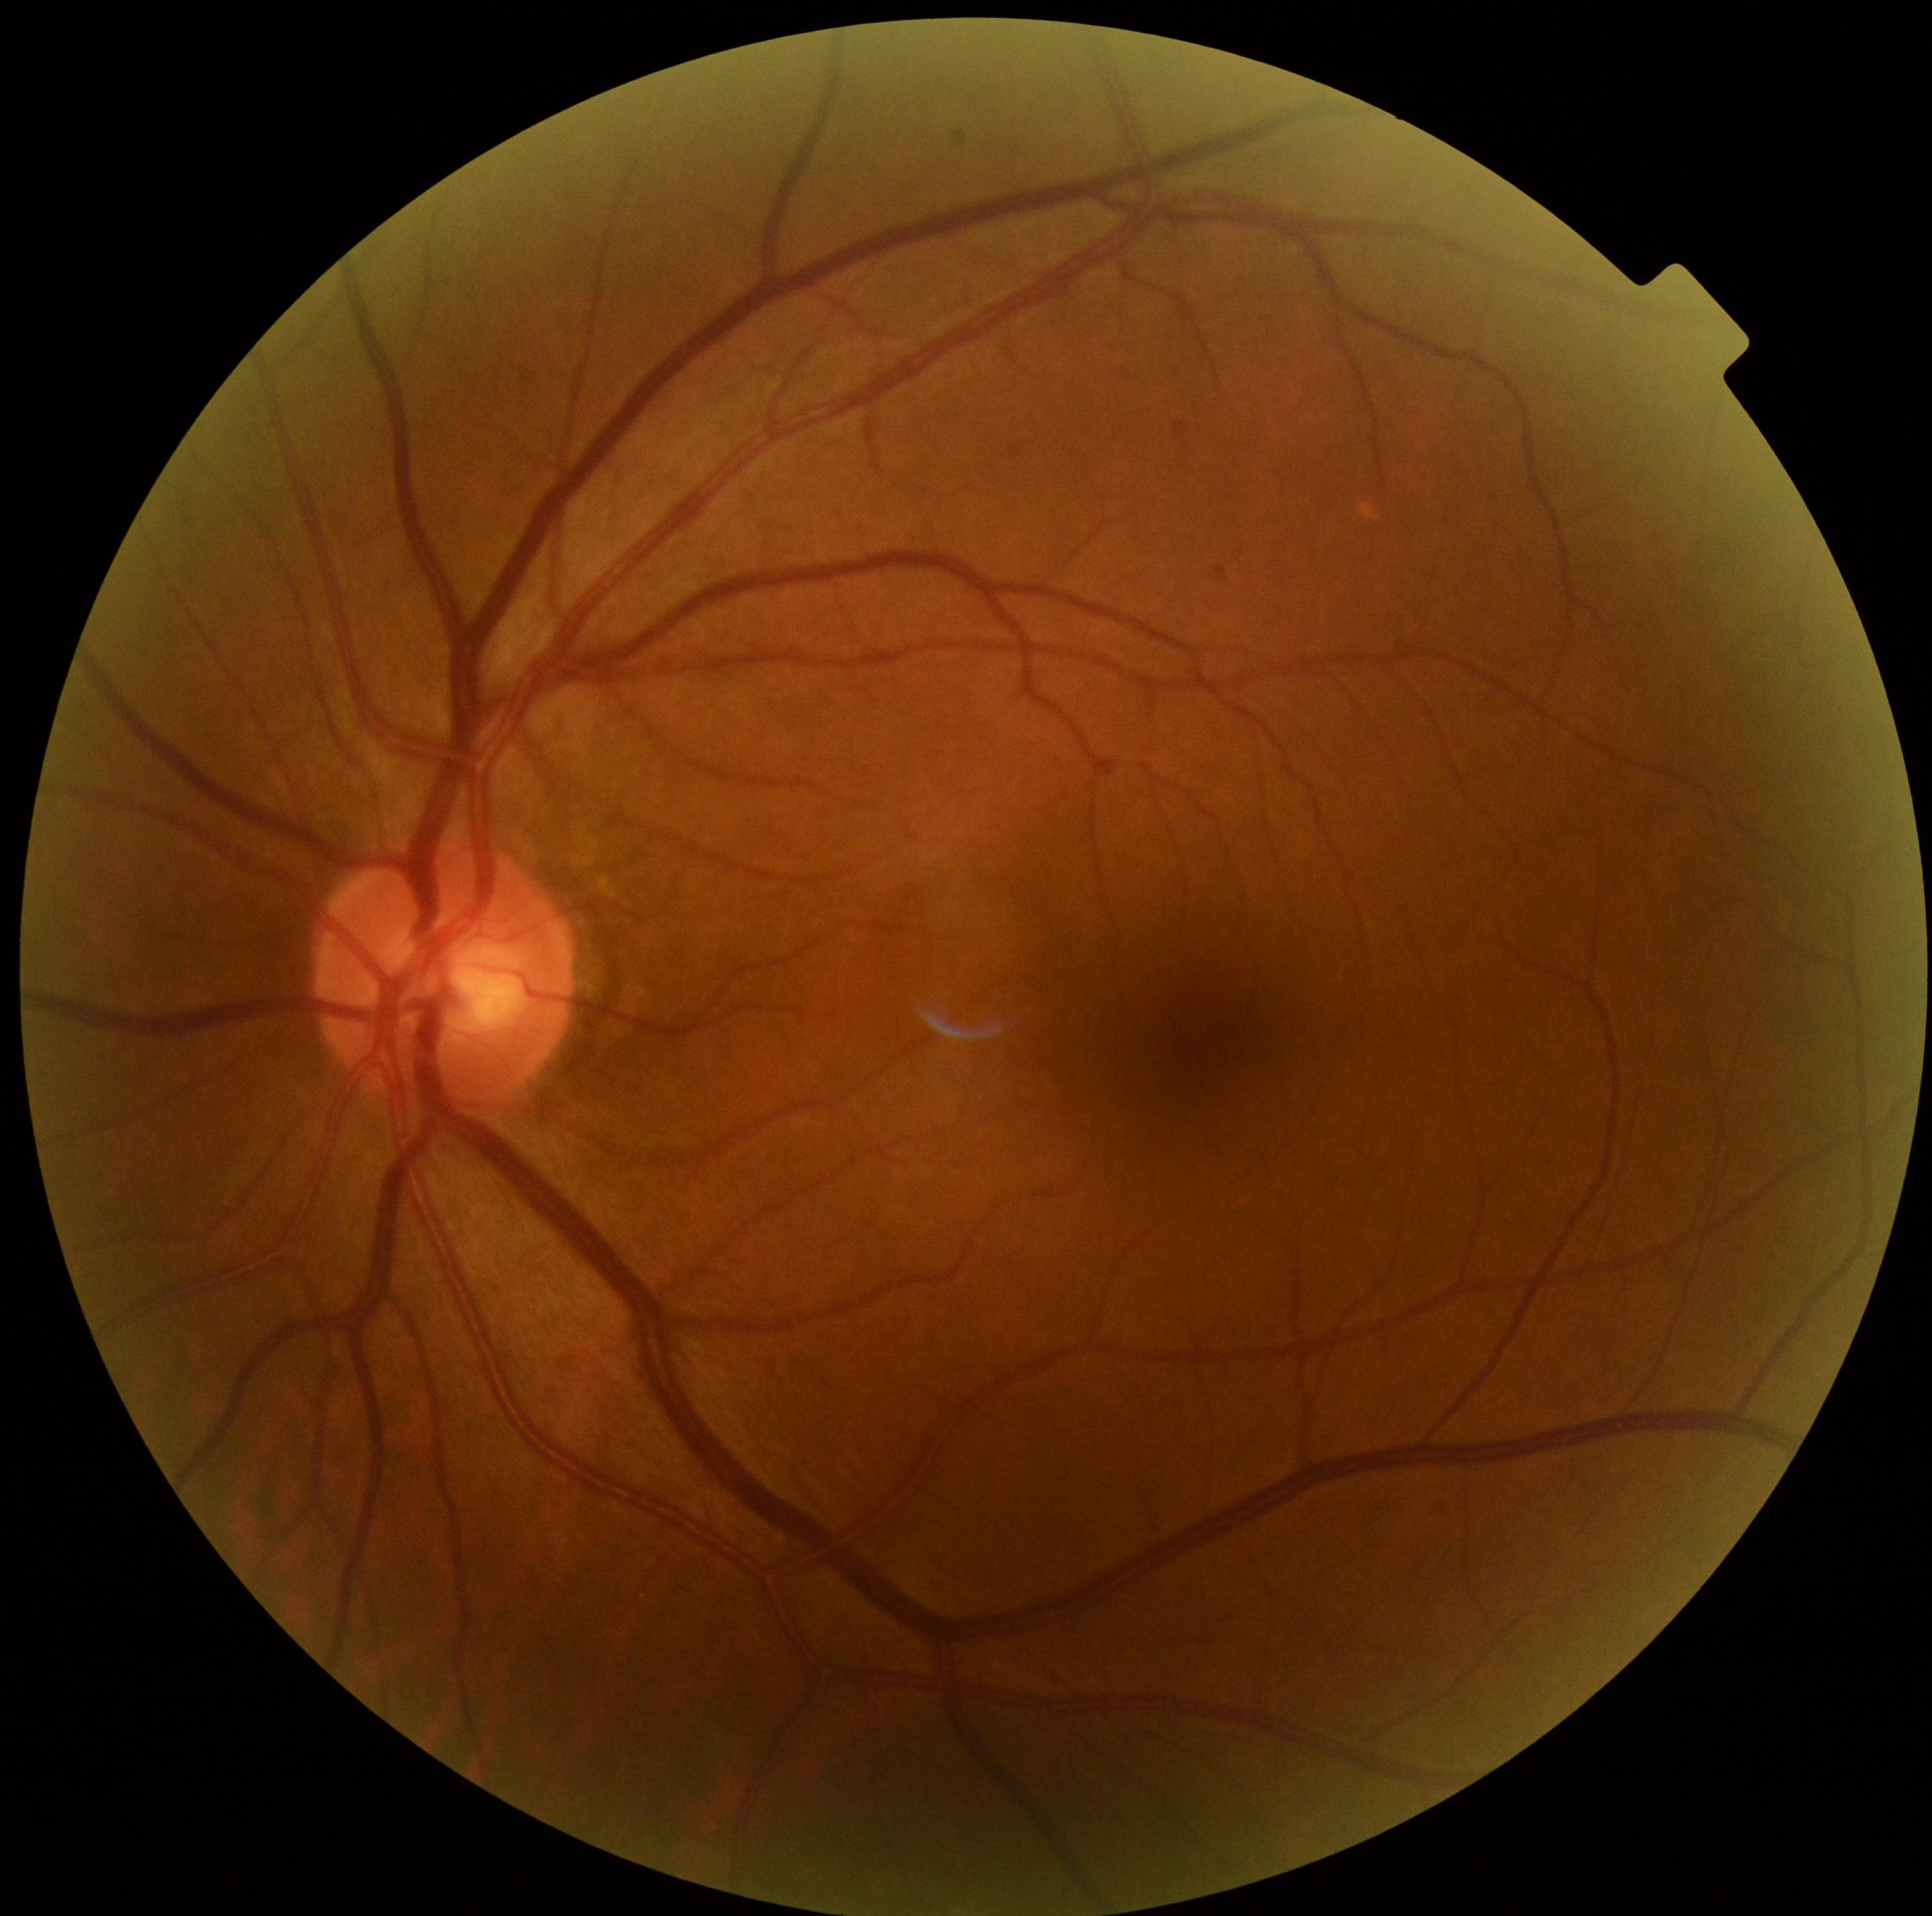

DR impression = no DR findings, diabetic retinopathy severity = no apparent diabetic retinopathy (grade 0) — no visible signs of diabetic retinopathy.